45-degree field of view — 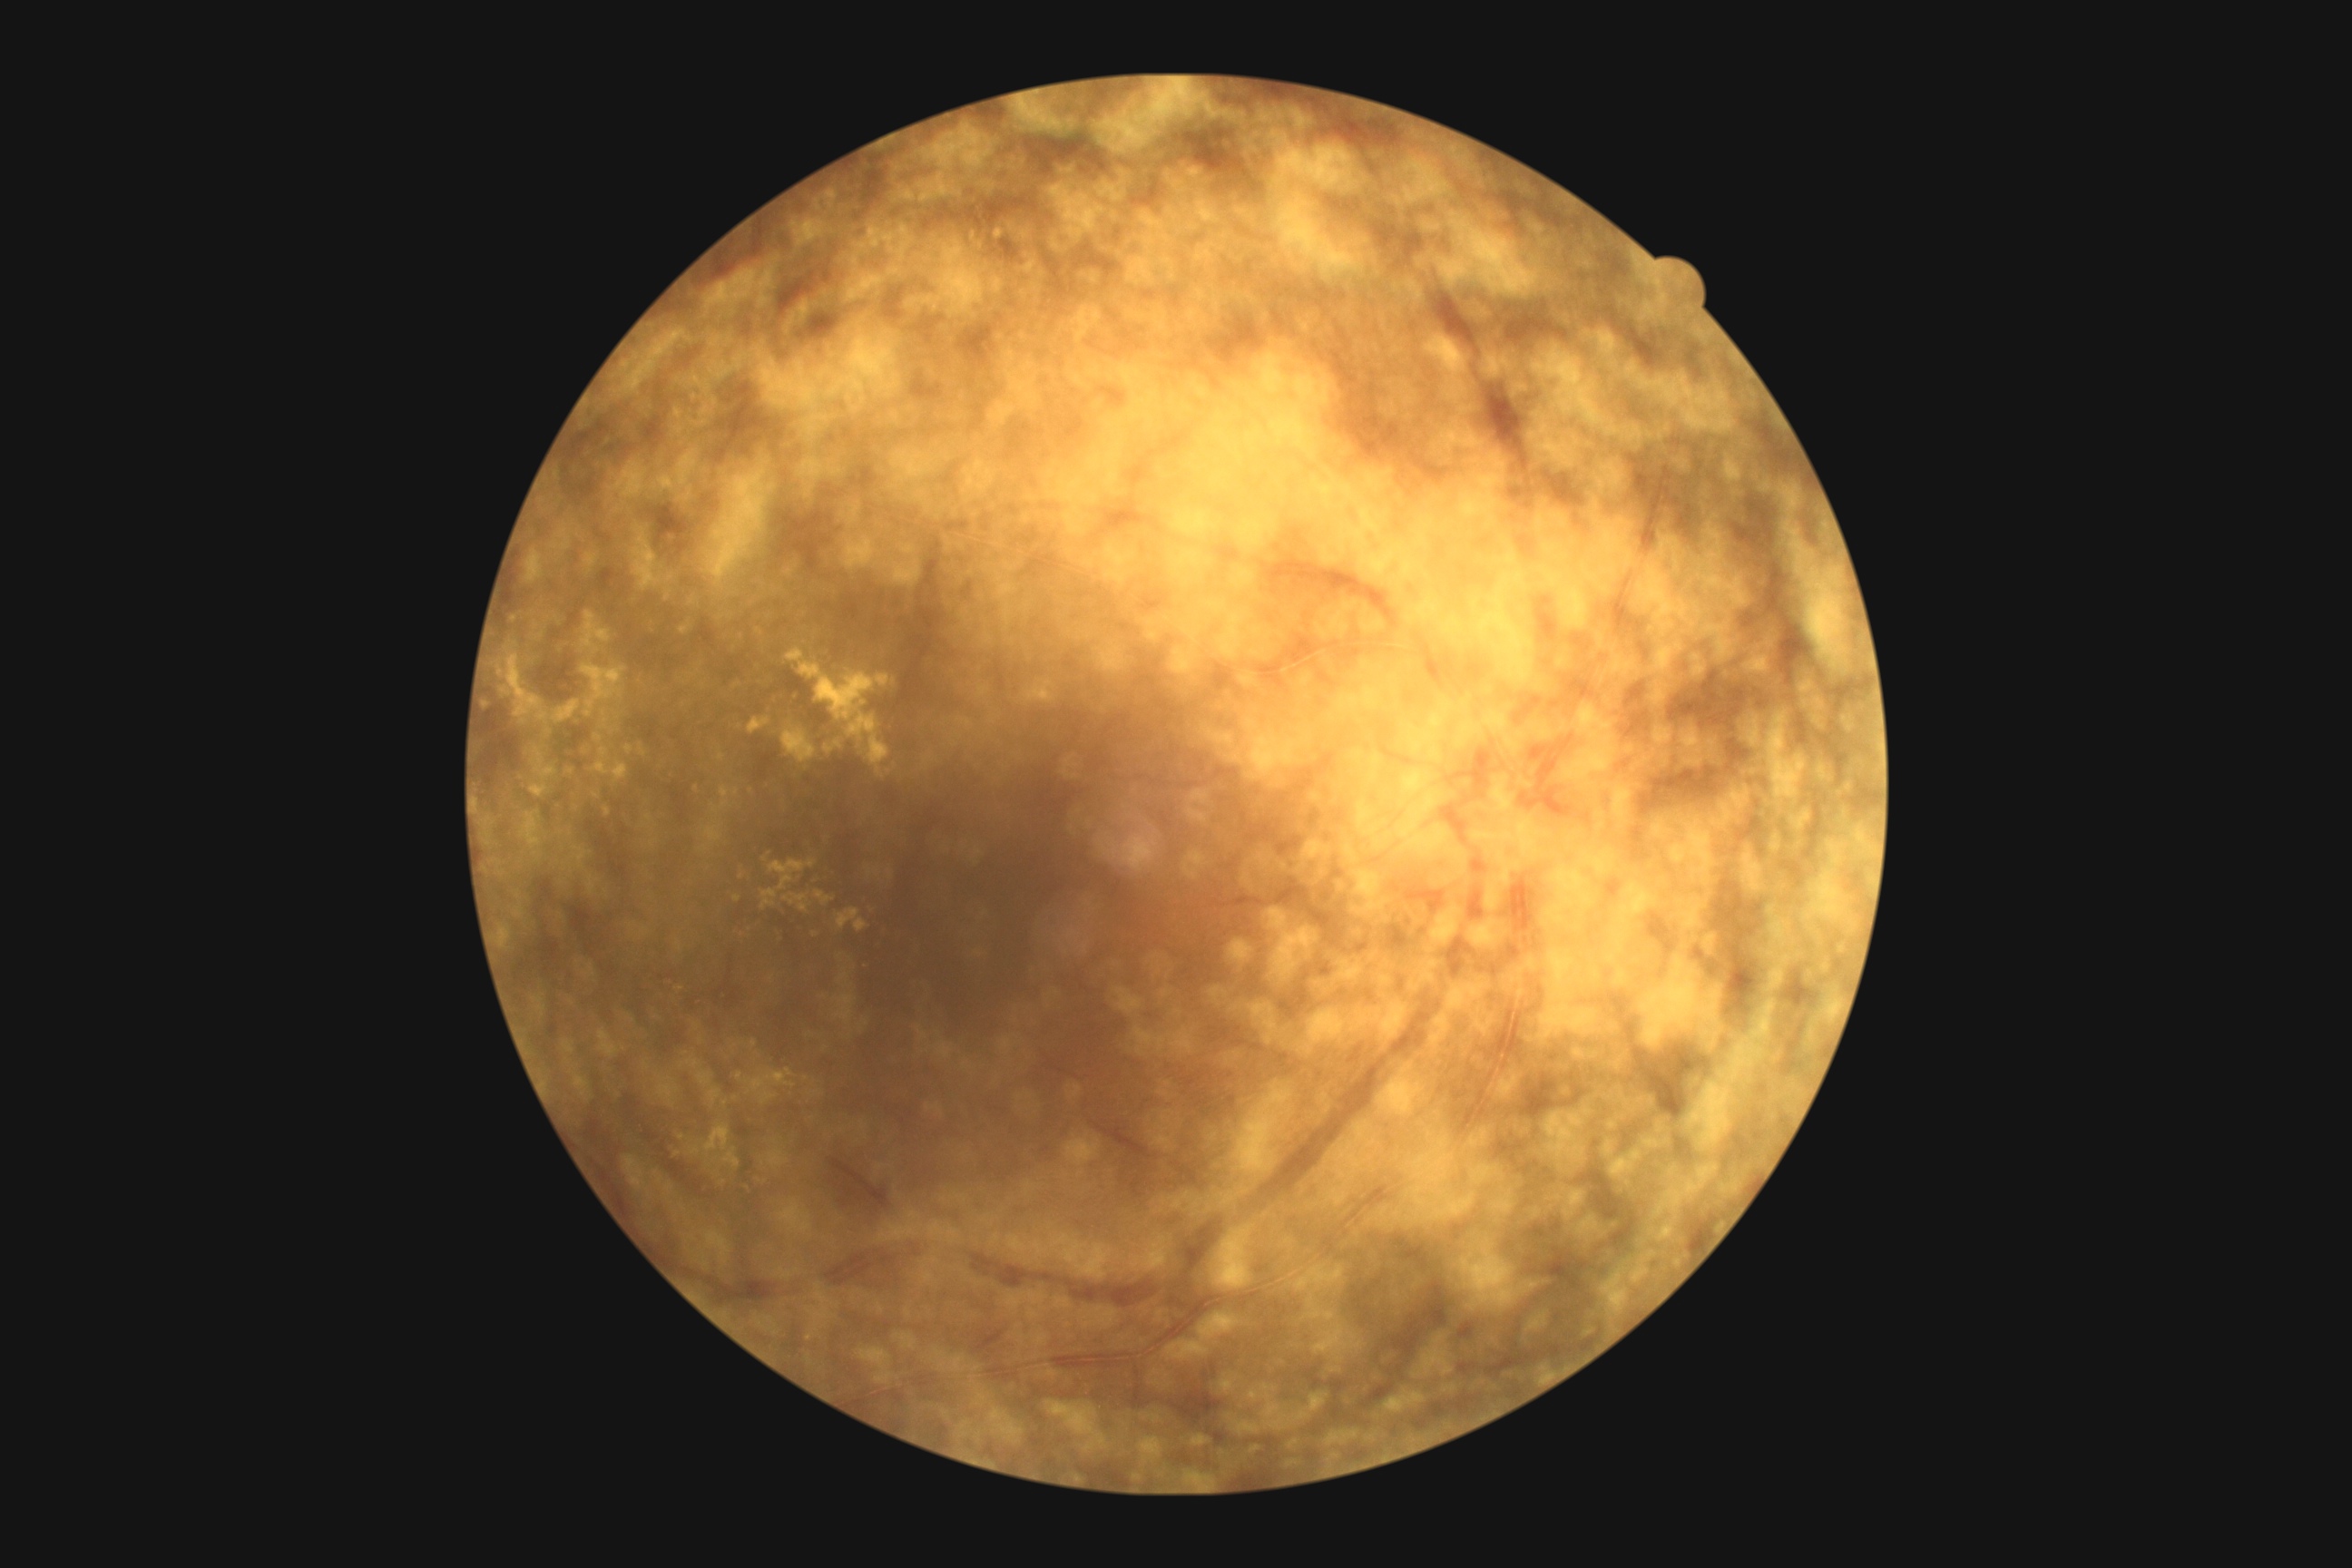 Diabetic retinopathy grade is 2 (moderate NPDR).